Fundus photo
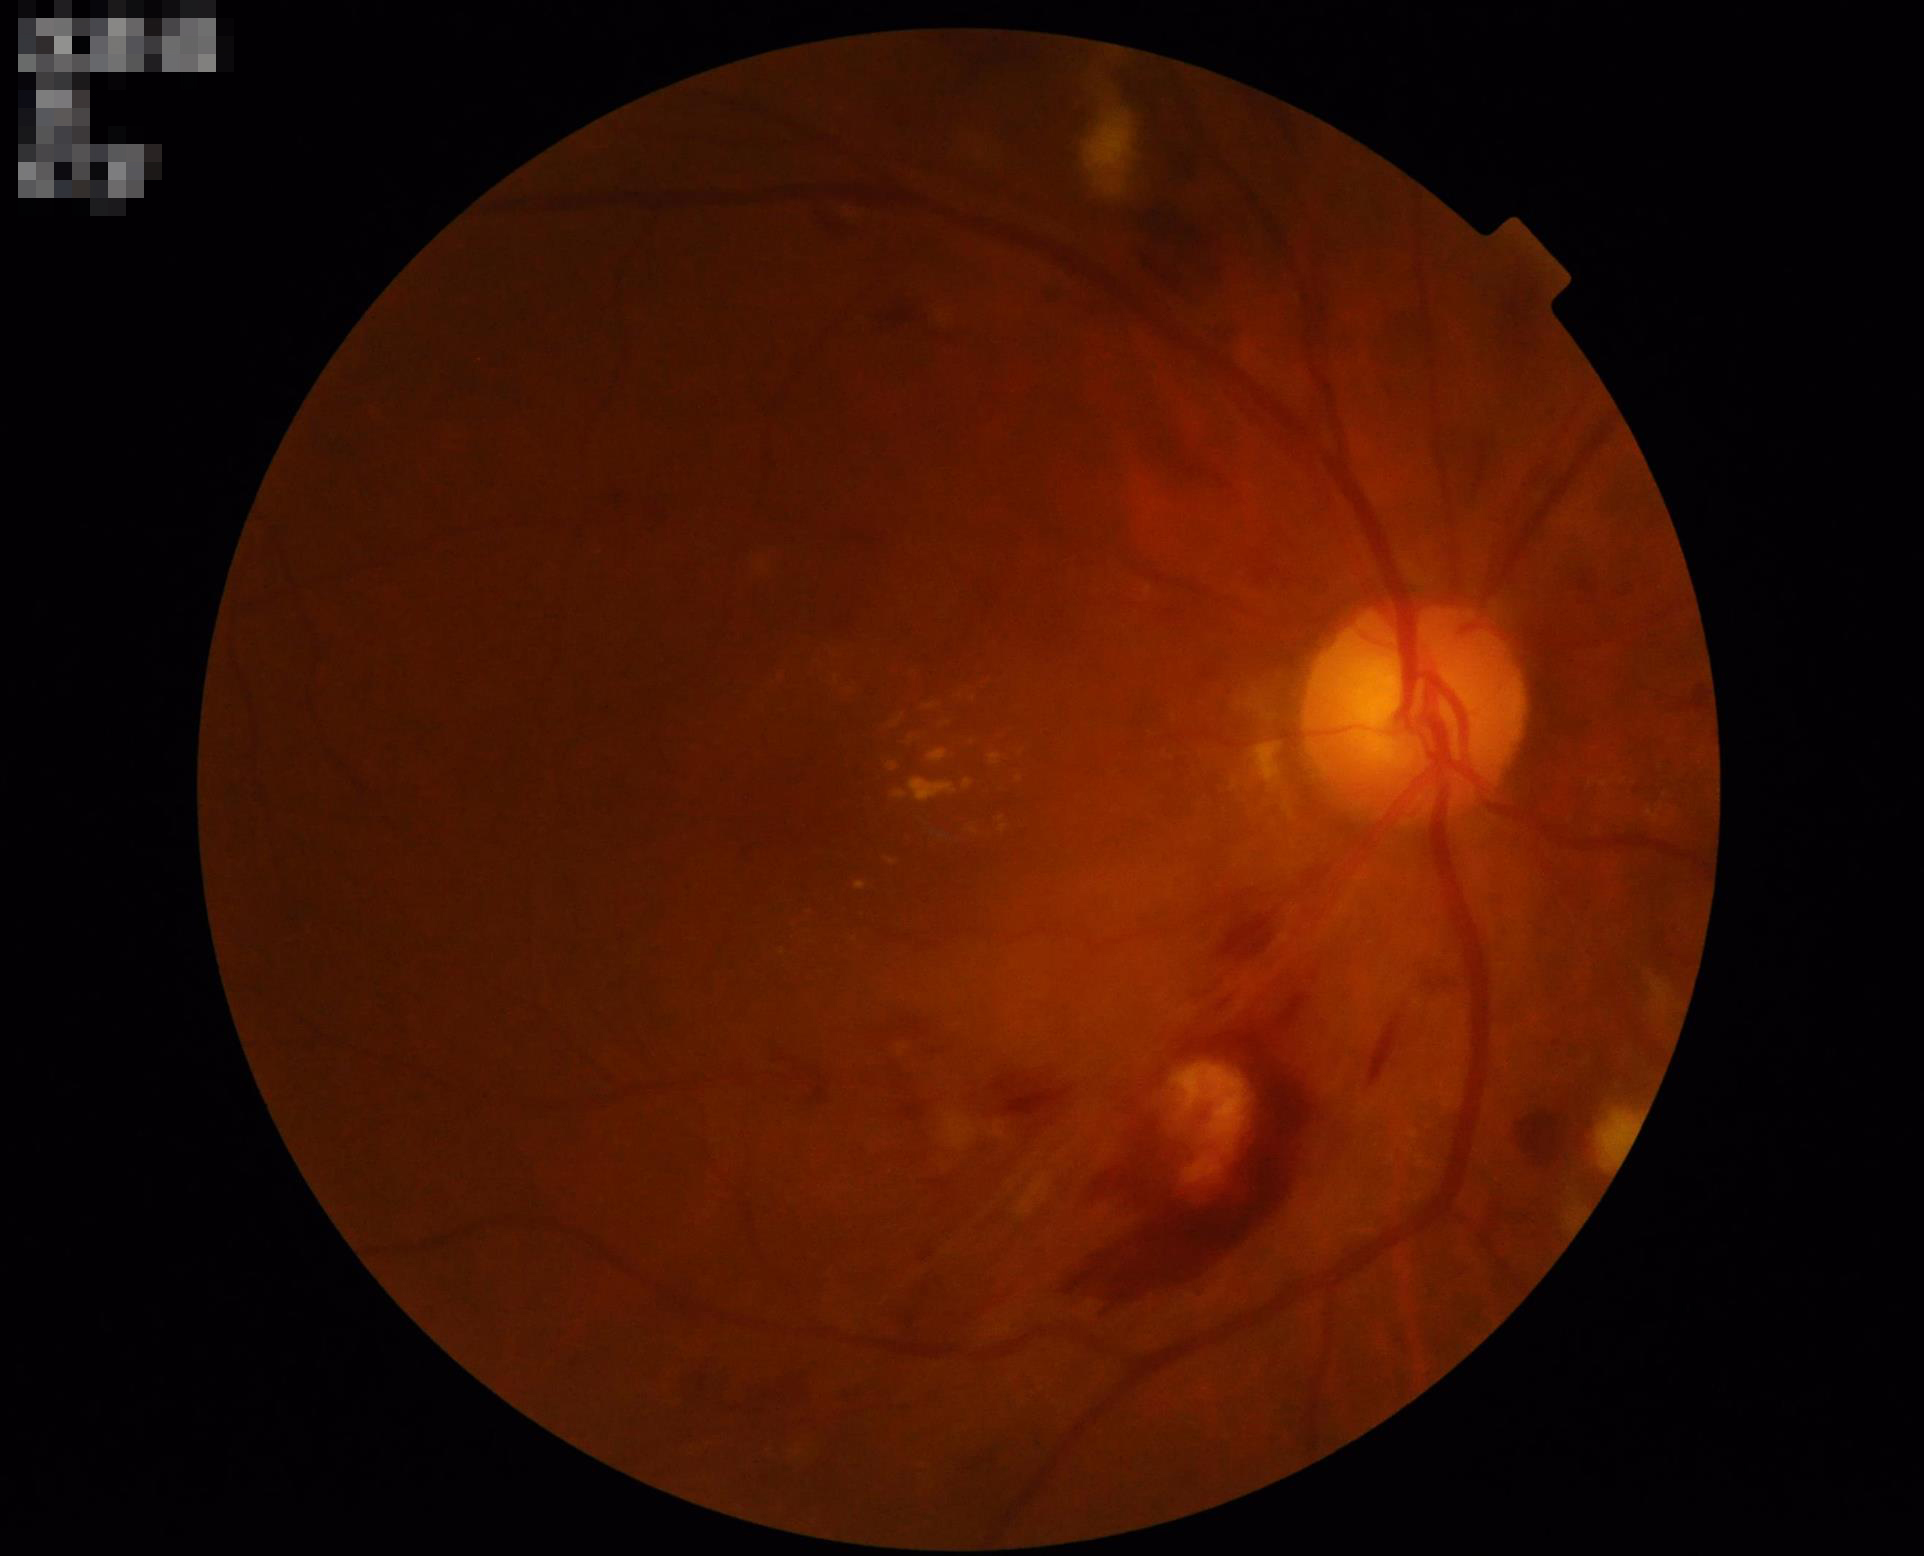

illumination: adequate
overall_quality: low
contrast: adequate
clarity: blurry